Graded on the modified Davis scale — 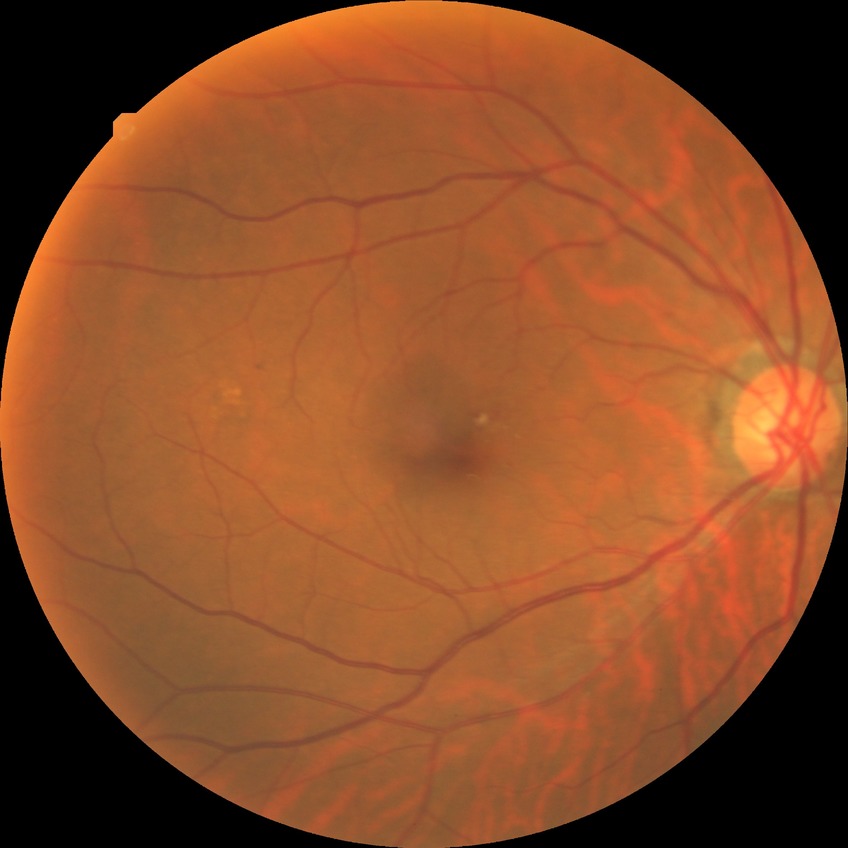 diabetic retinopathy (DR) = NDR (no diabetic retinopathy)